Retinal fundus photograph: 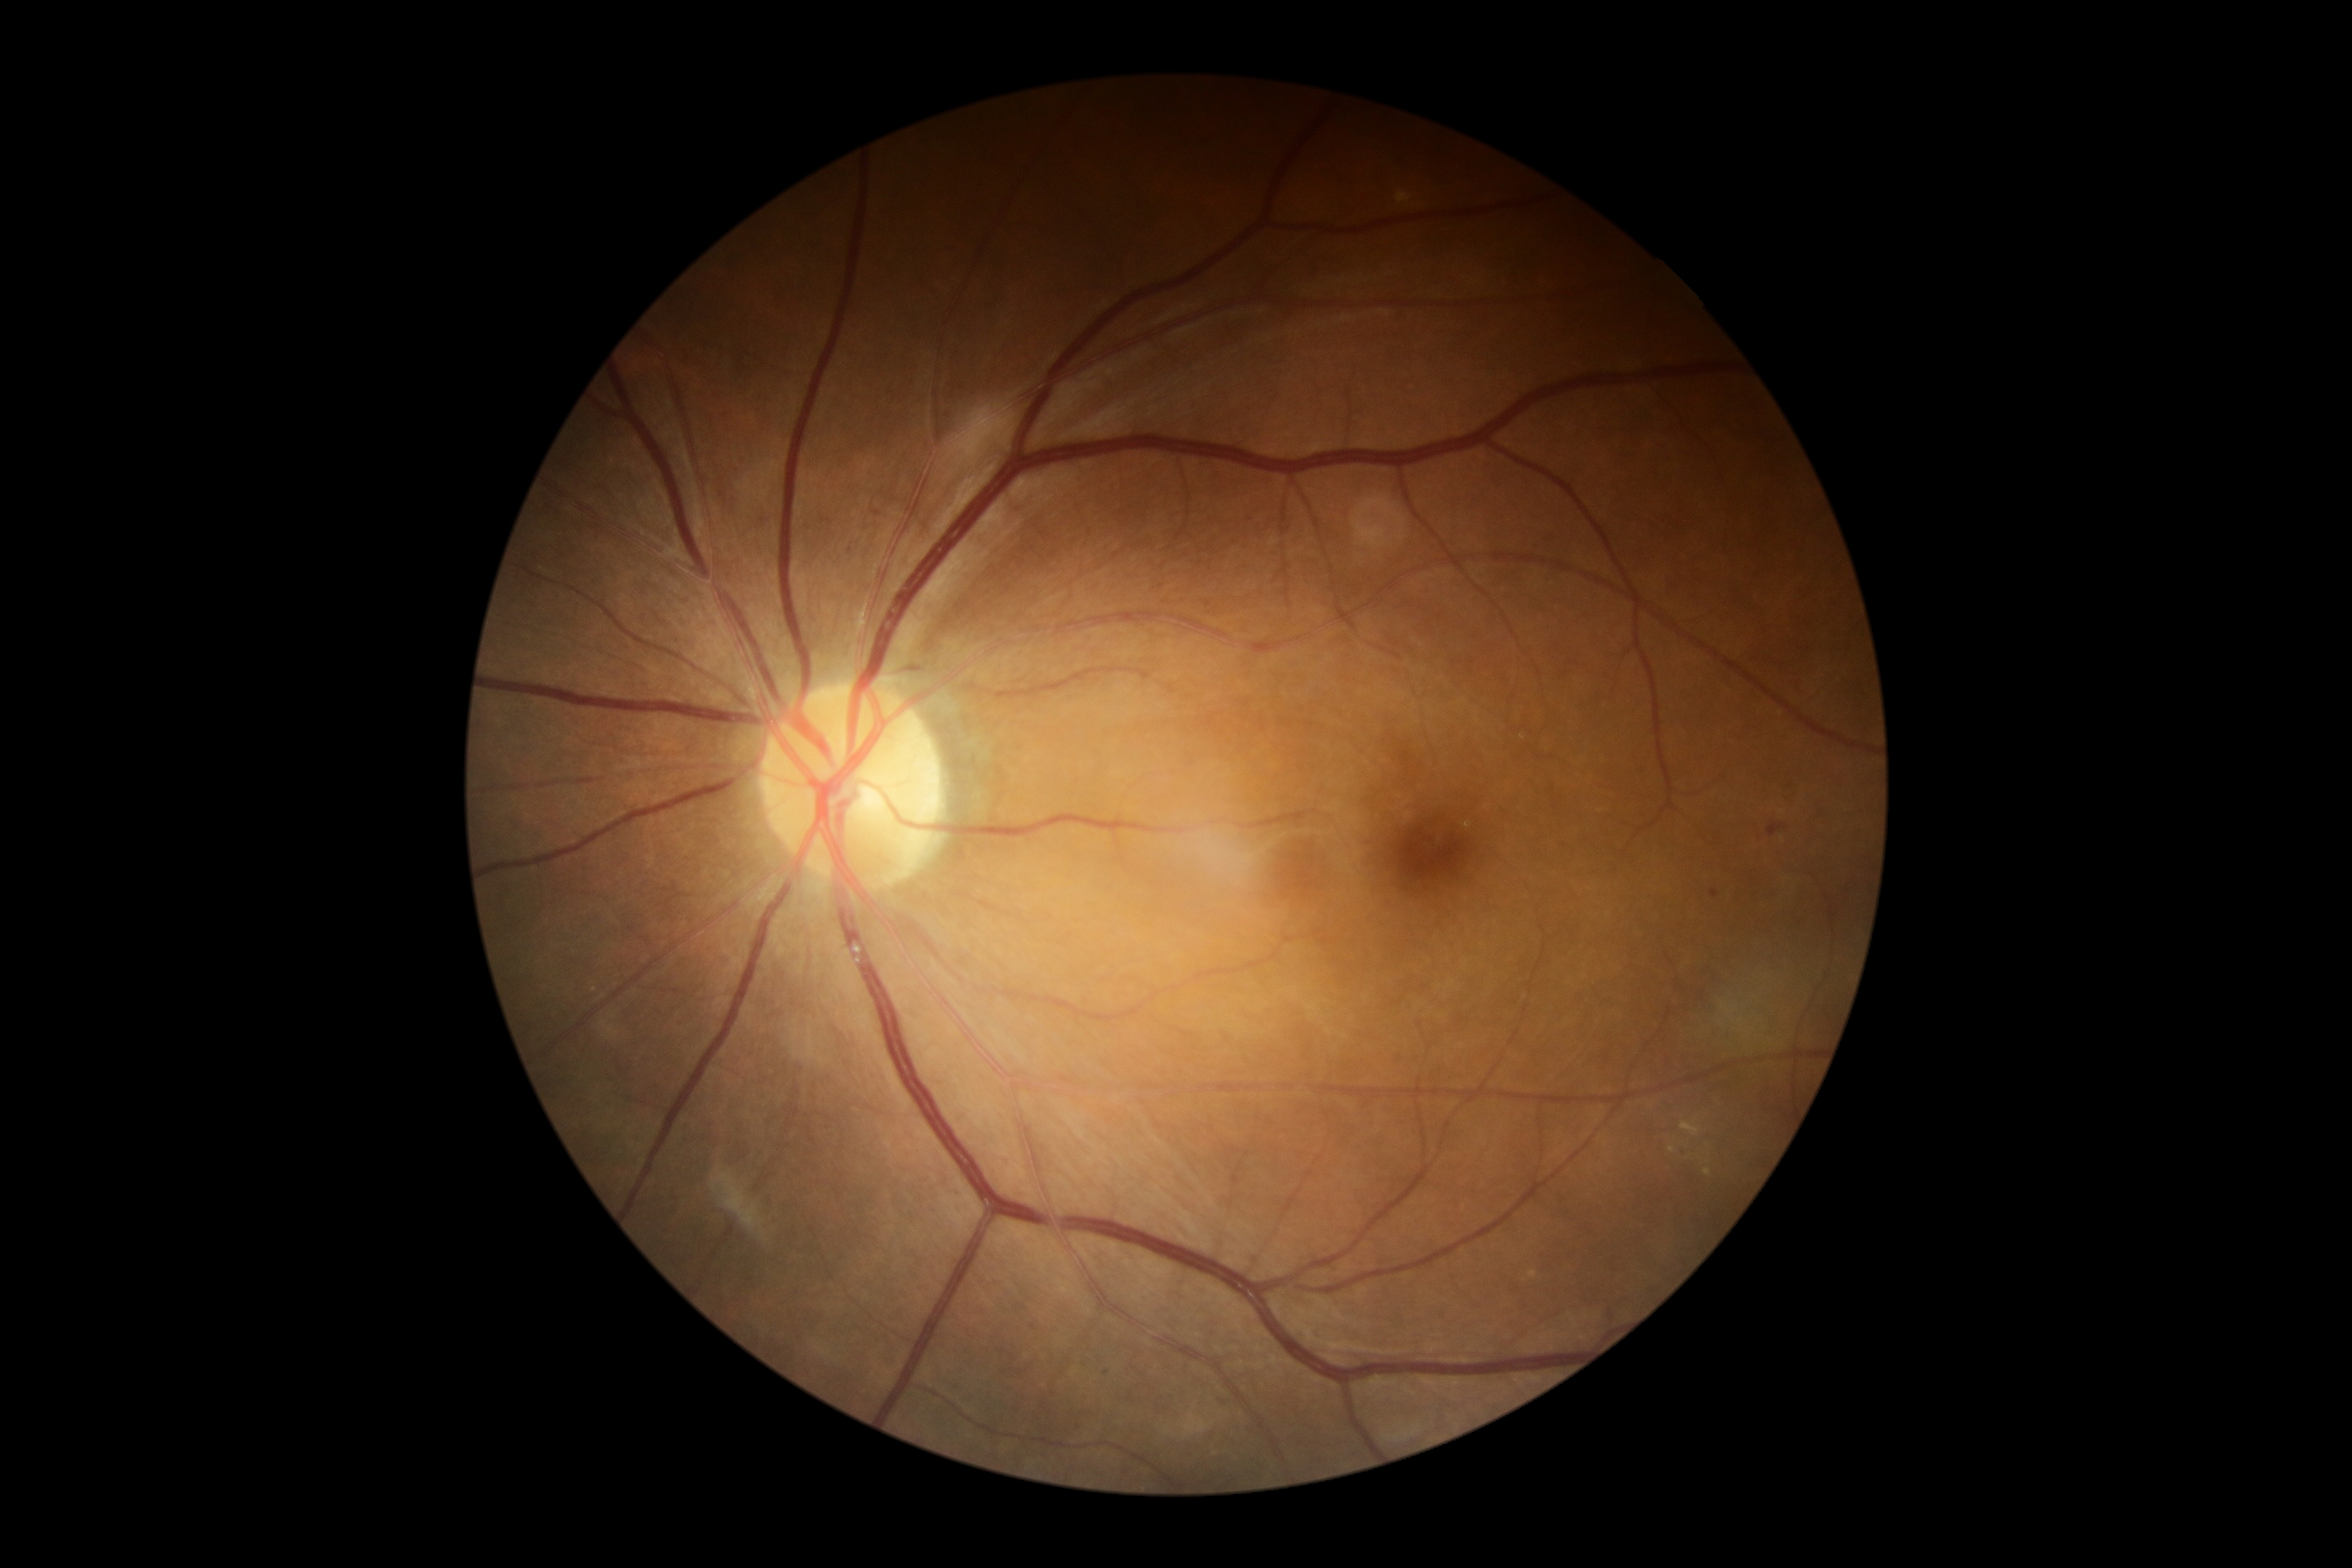
DR severity is moderate non-proliferative diabetic retinopathy (grade 2).